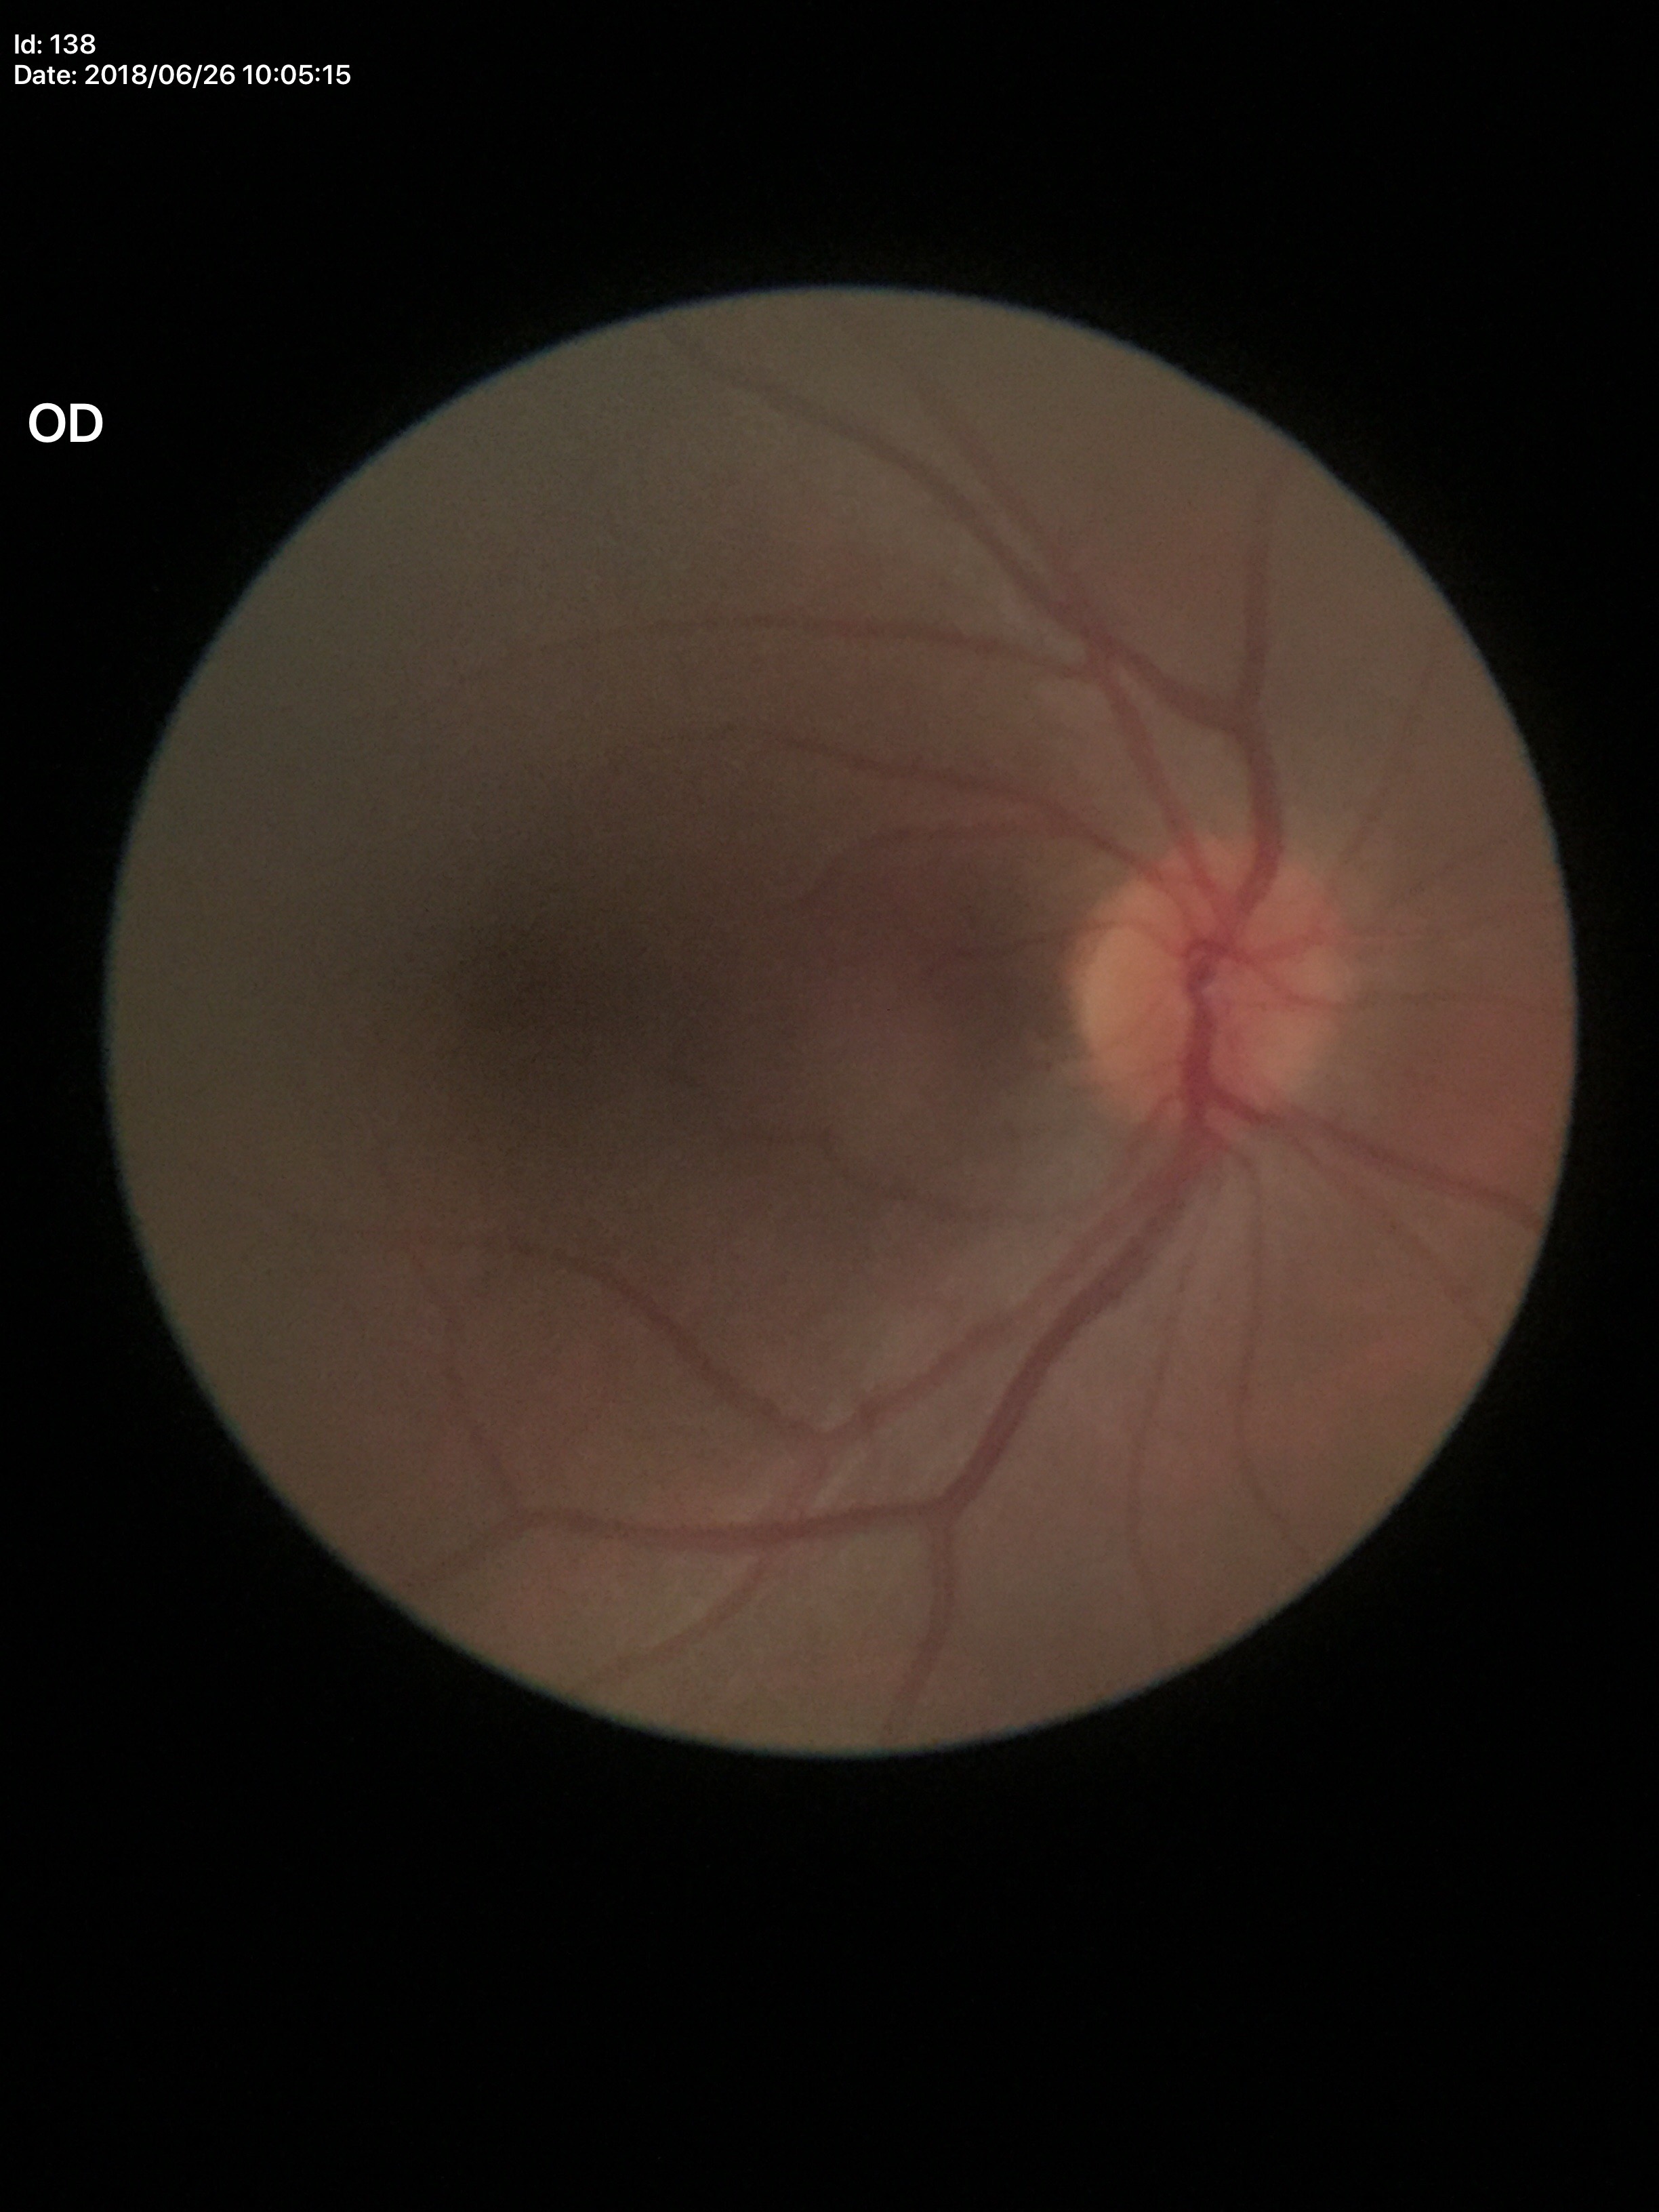

Glaucoma assessment: not suspect (5/5 ophthalmologists in agreement).
Horizontal CDR (HCDR) of 0.40.
Vertical C/D ratio (VCDR) is 0.39.